CFP. 45° FOV. 2048x1536px — 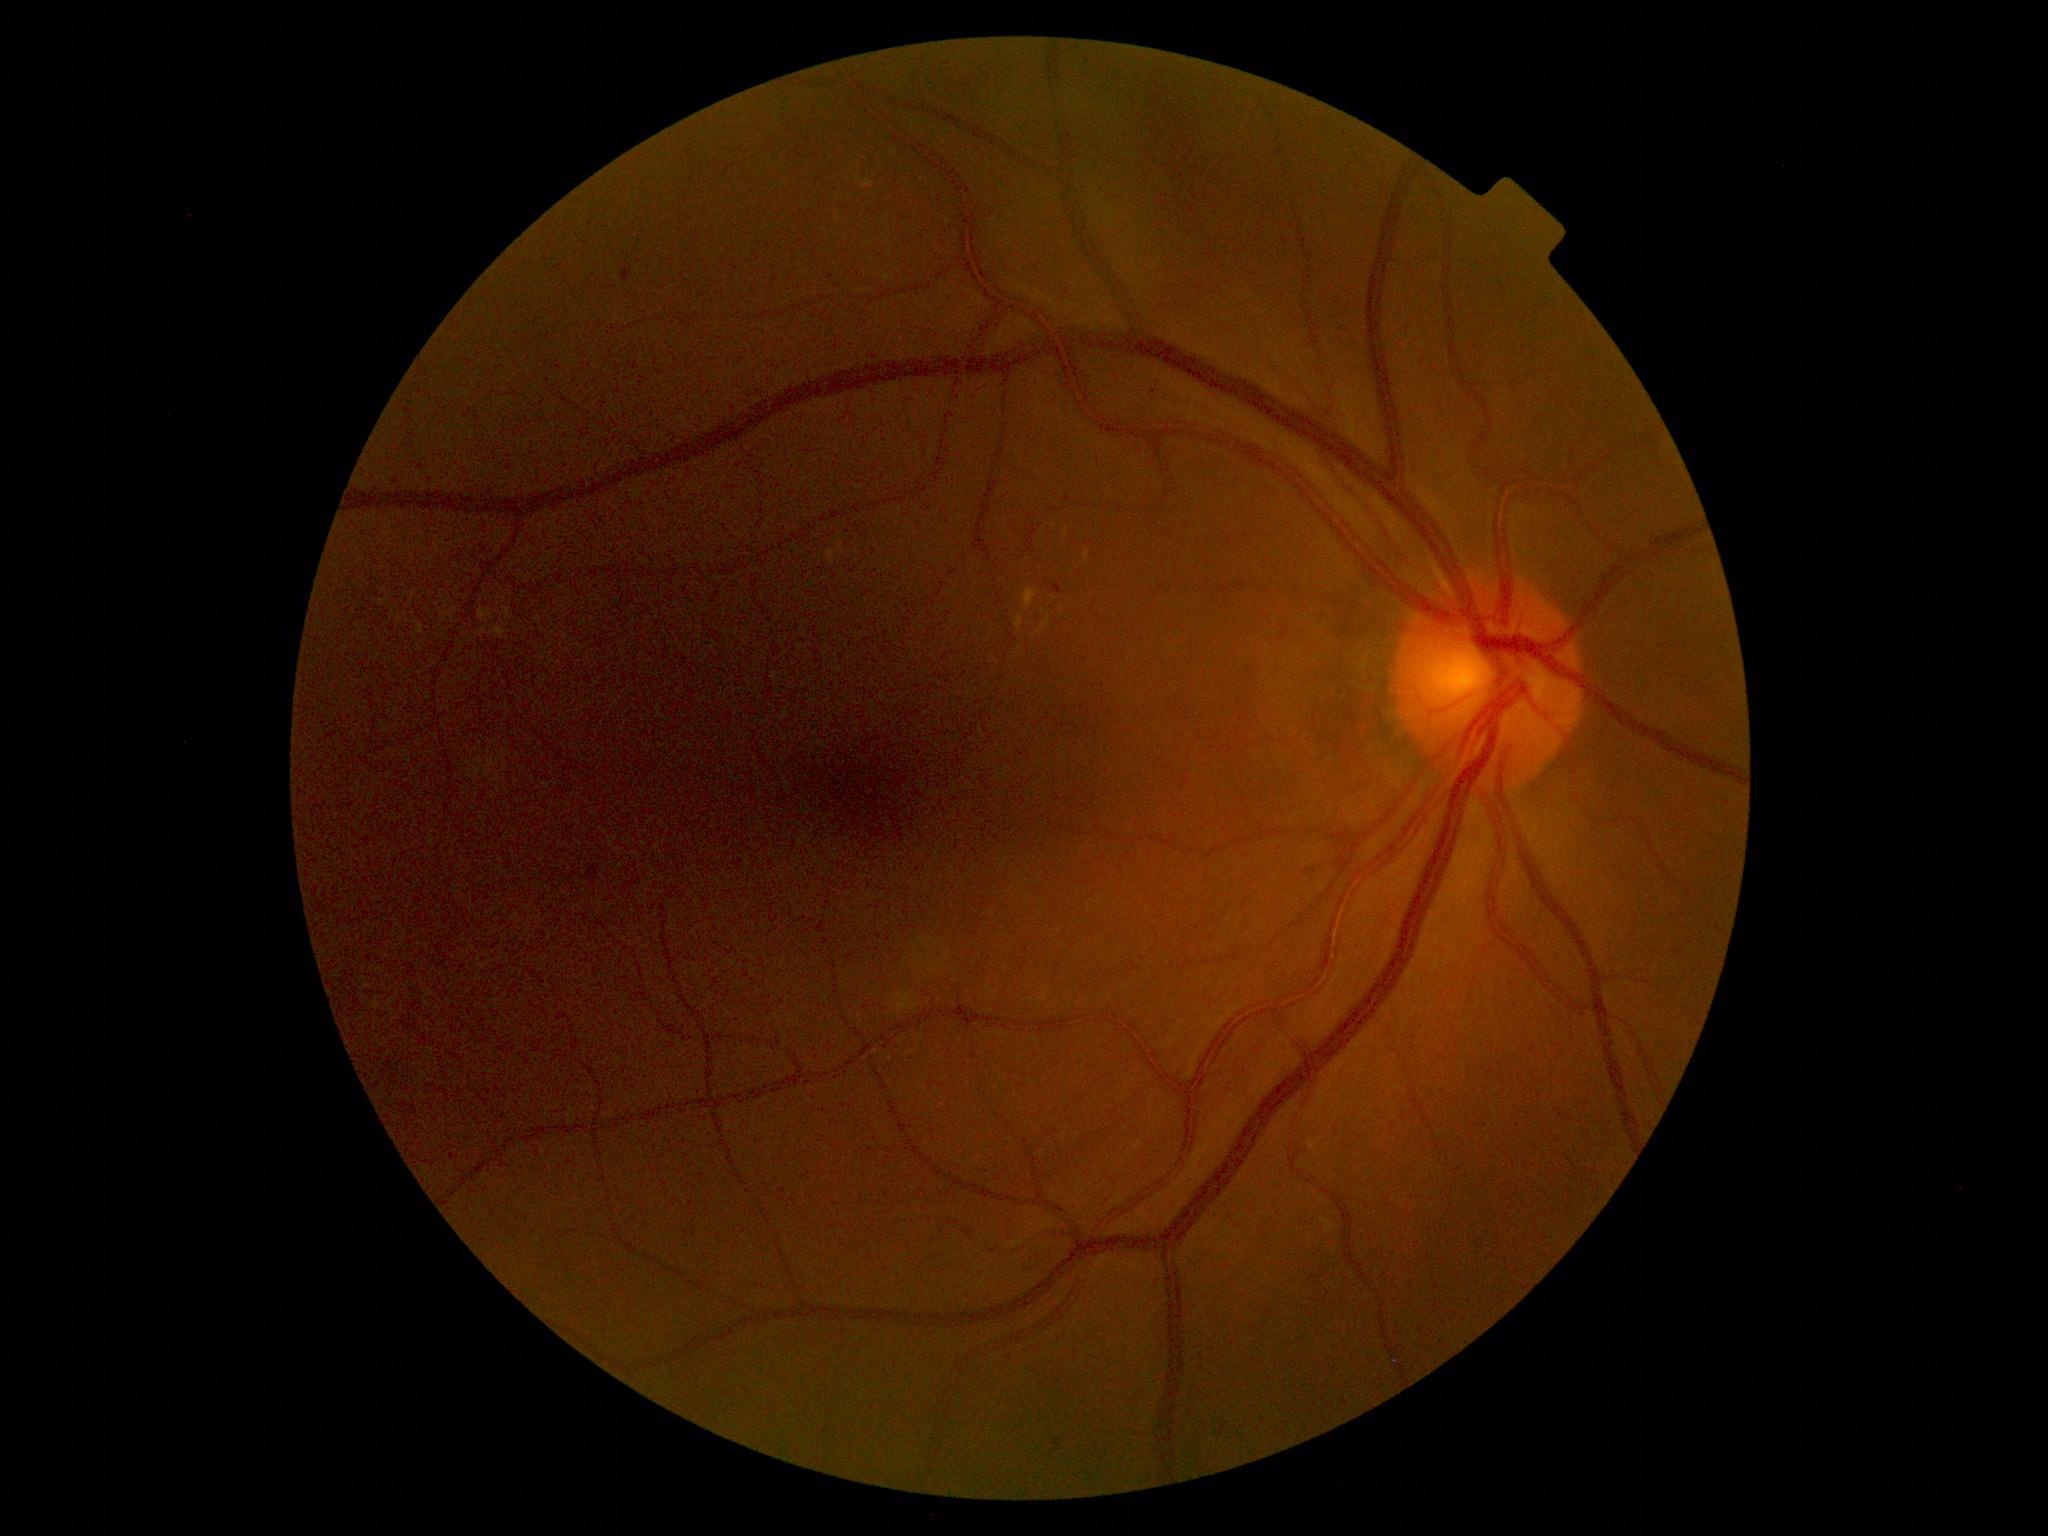
Diabetic retinopathy (DR): grade 2 (moderate NPDR).